FOV: 45 degrees · color fundus image · 2352 x 1568 pixels: 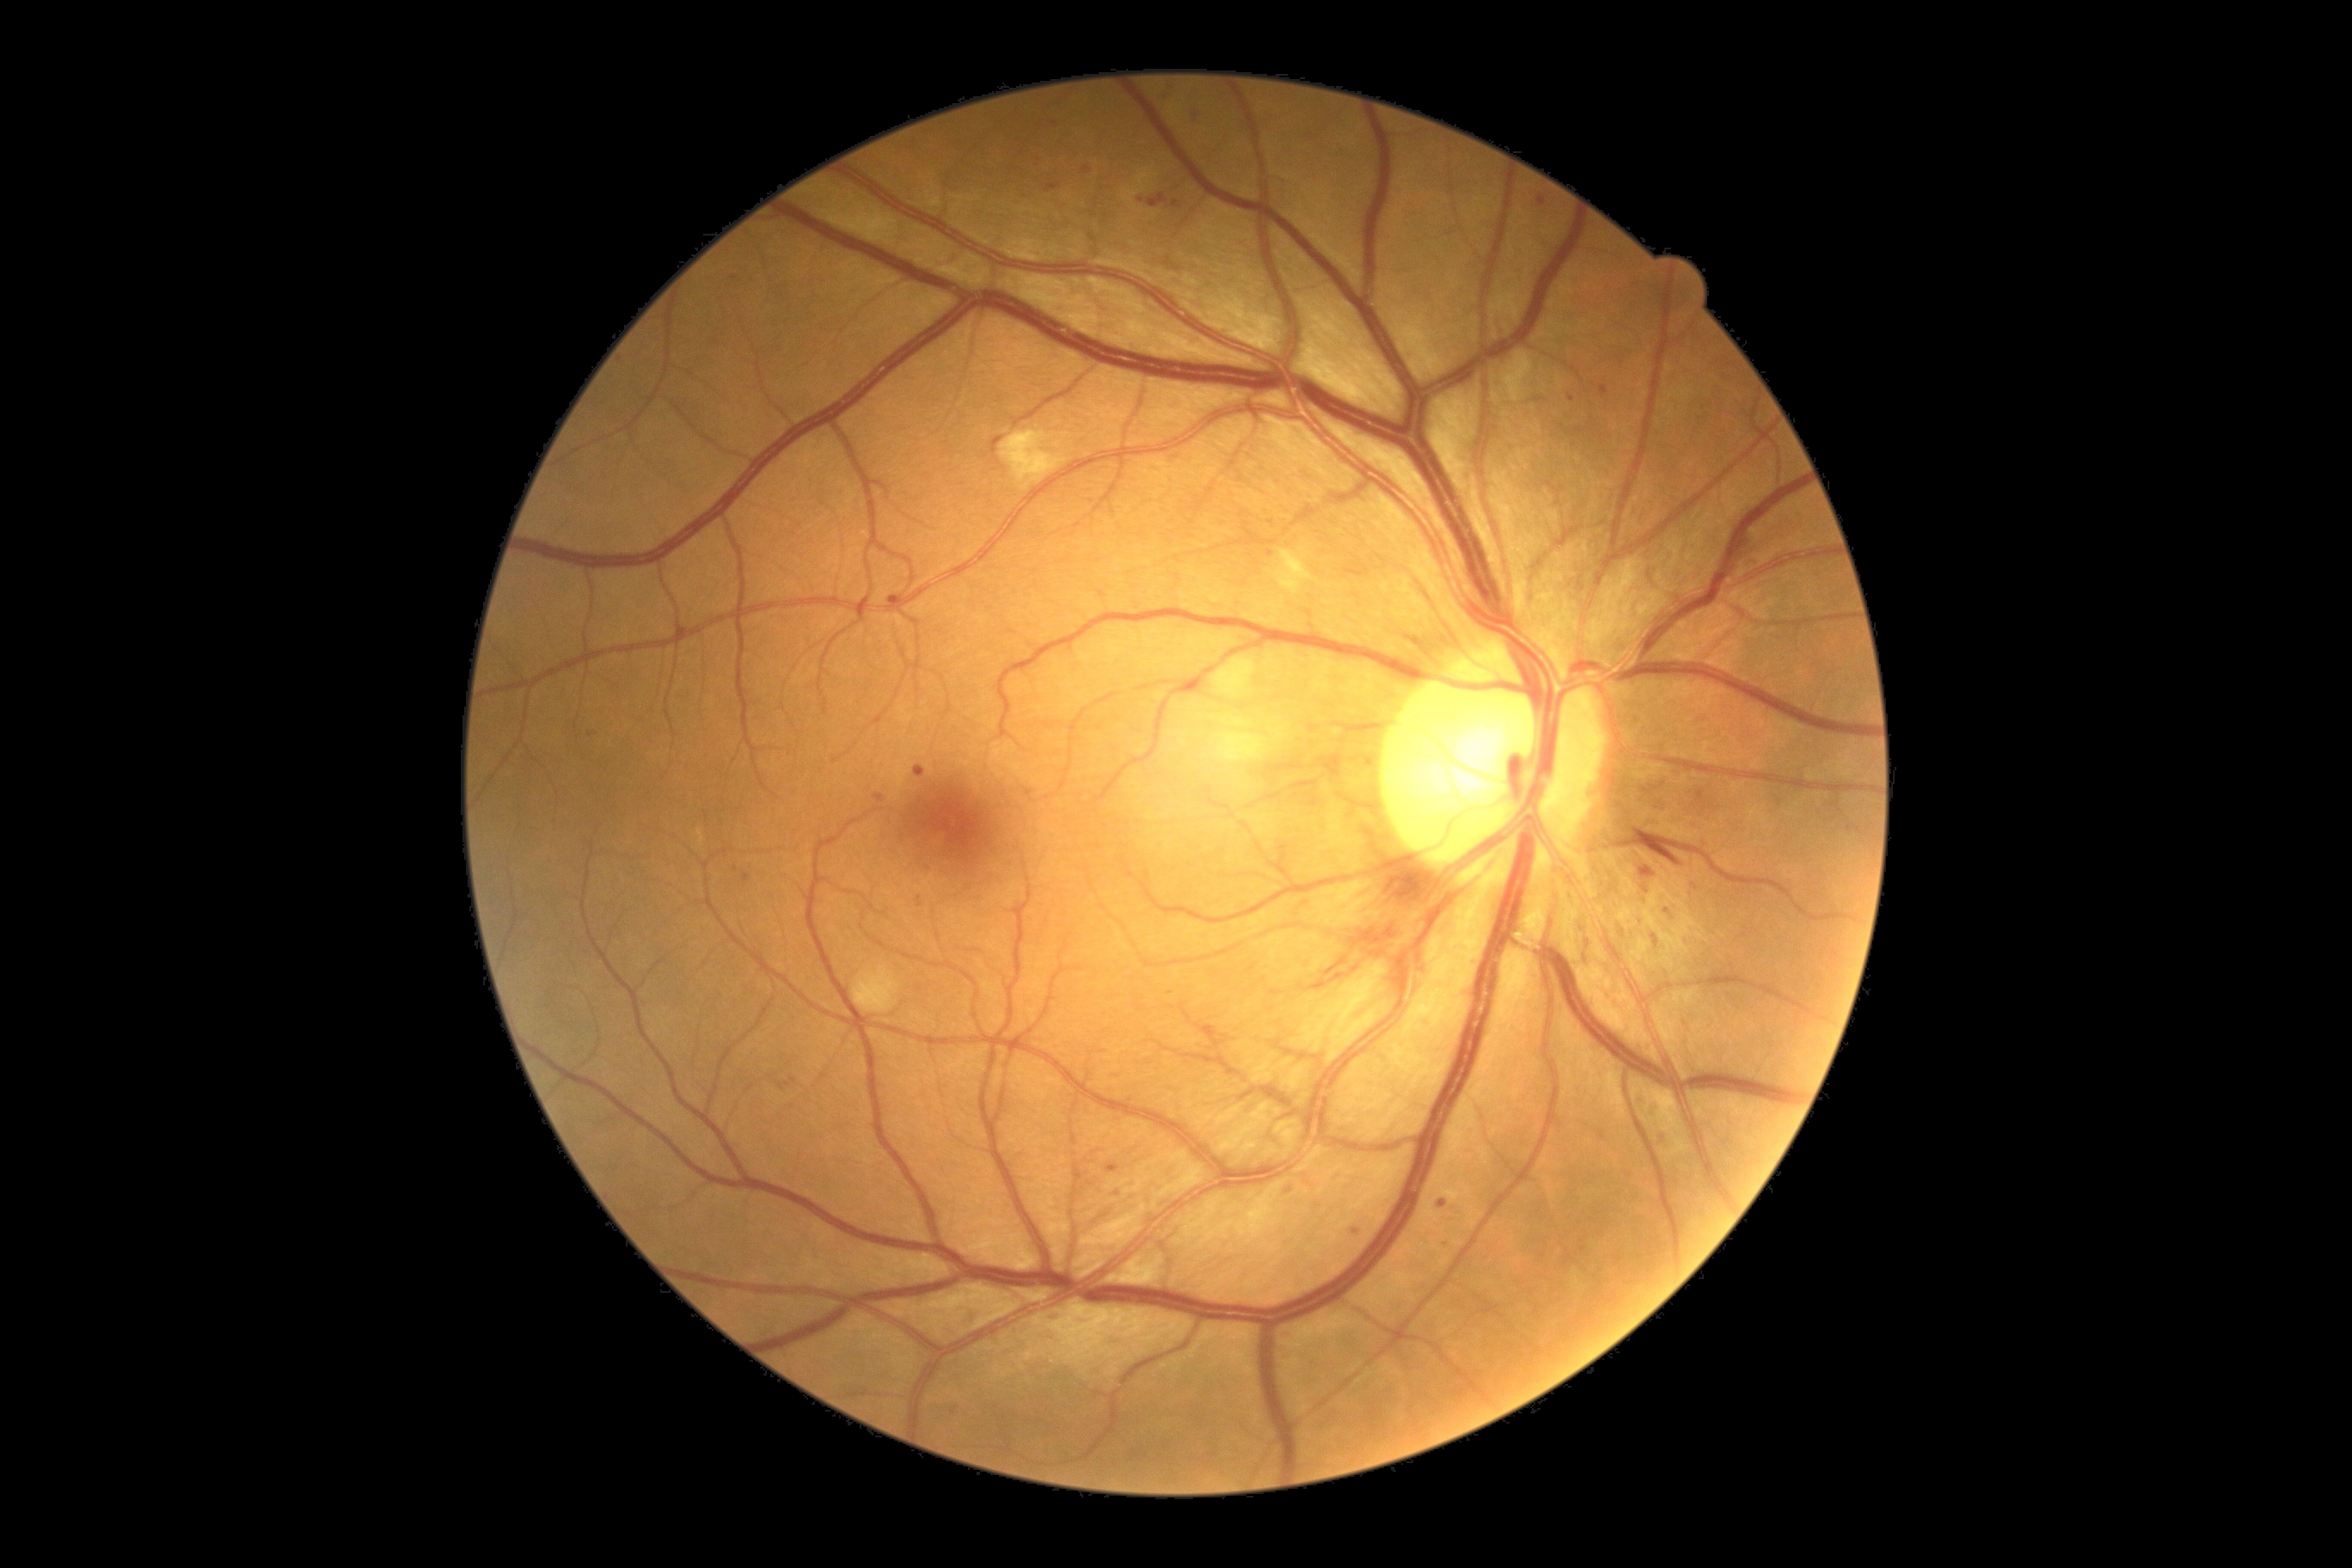

Diabetic retinopathy (DR) is grade 2 (moderate NPDR).
Microaneurysms (MAs) include those at left=1332, top=757, right=1344, bottom=776; left=1050, top=1316, right=1062, bottom=1326; left=1600, top=386, right=1608, bottom=396; left=776, top=1077, right=799, bottom=1091; left=1658, top=804, right=1667, bottom=812; left=873, top=795, right=885, bottom=804; left=744, top=873, right=752, bottom=883; left=917, top=897, right=922, bottom=907; left=1636, top=1094, right=1651, bottom=1106; left=1653, top=1110, right=1662, bottom=1122; left=1172, top=200, right=1179, bottom=209.
Additional small MAs near Point(1704, 809); Point(1170, 994); Point(1289, 1191); Point(1054, 123); Point(1644, 903); Point(953, 1413); Point(1744, 936).